Color fundus image
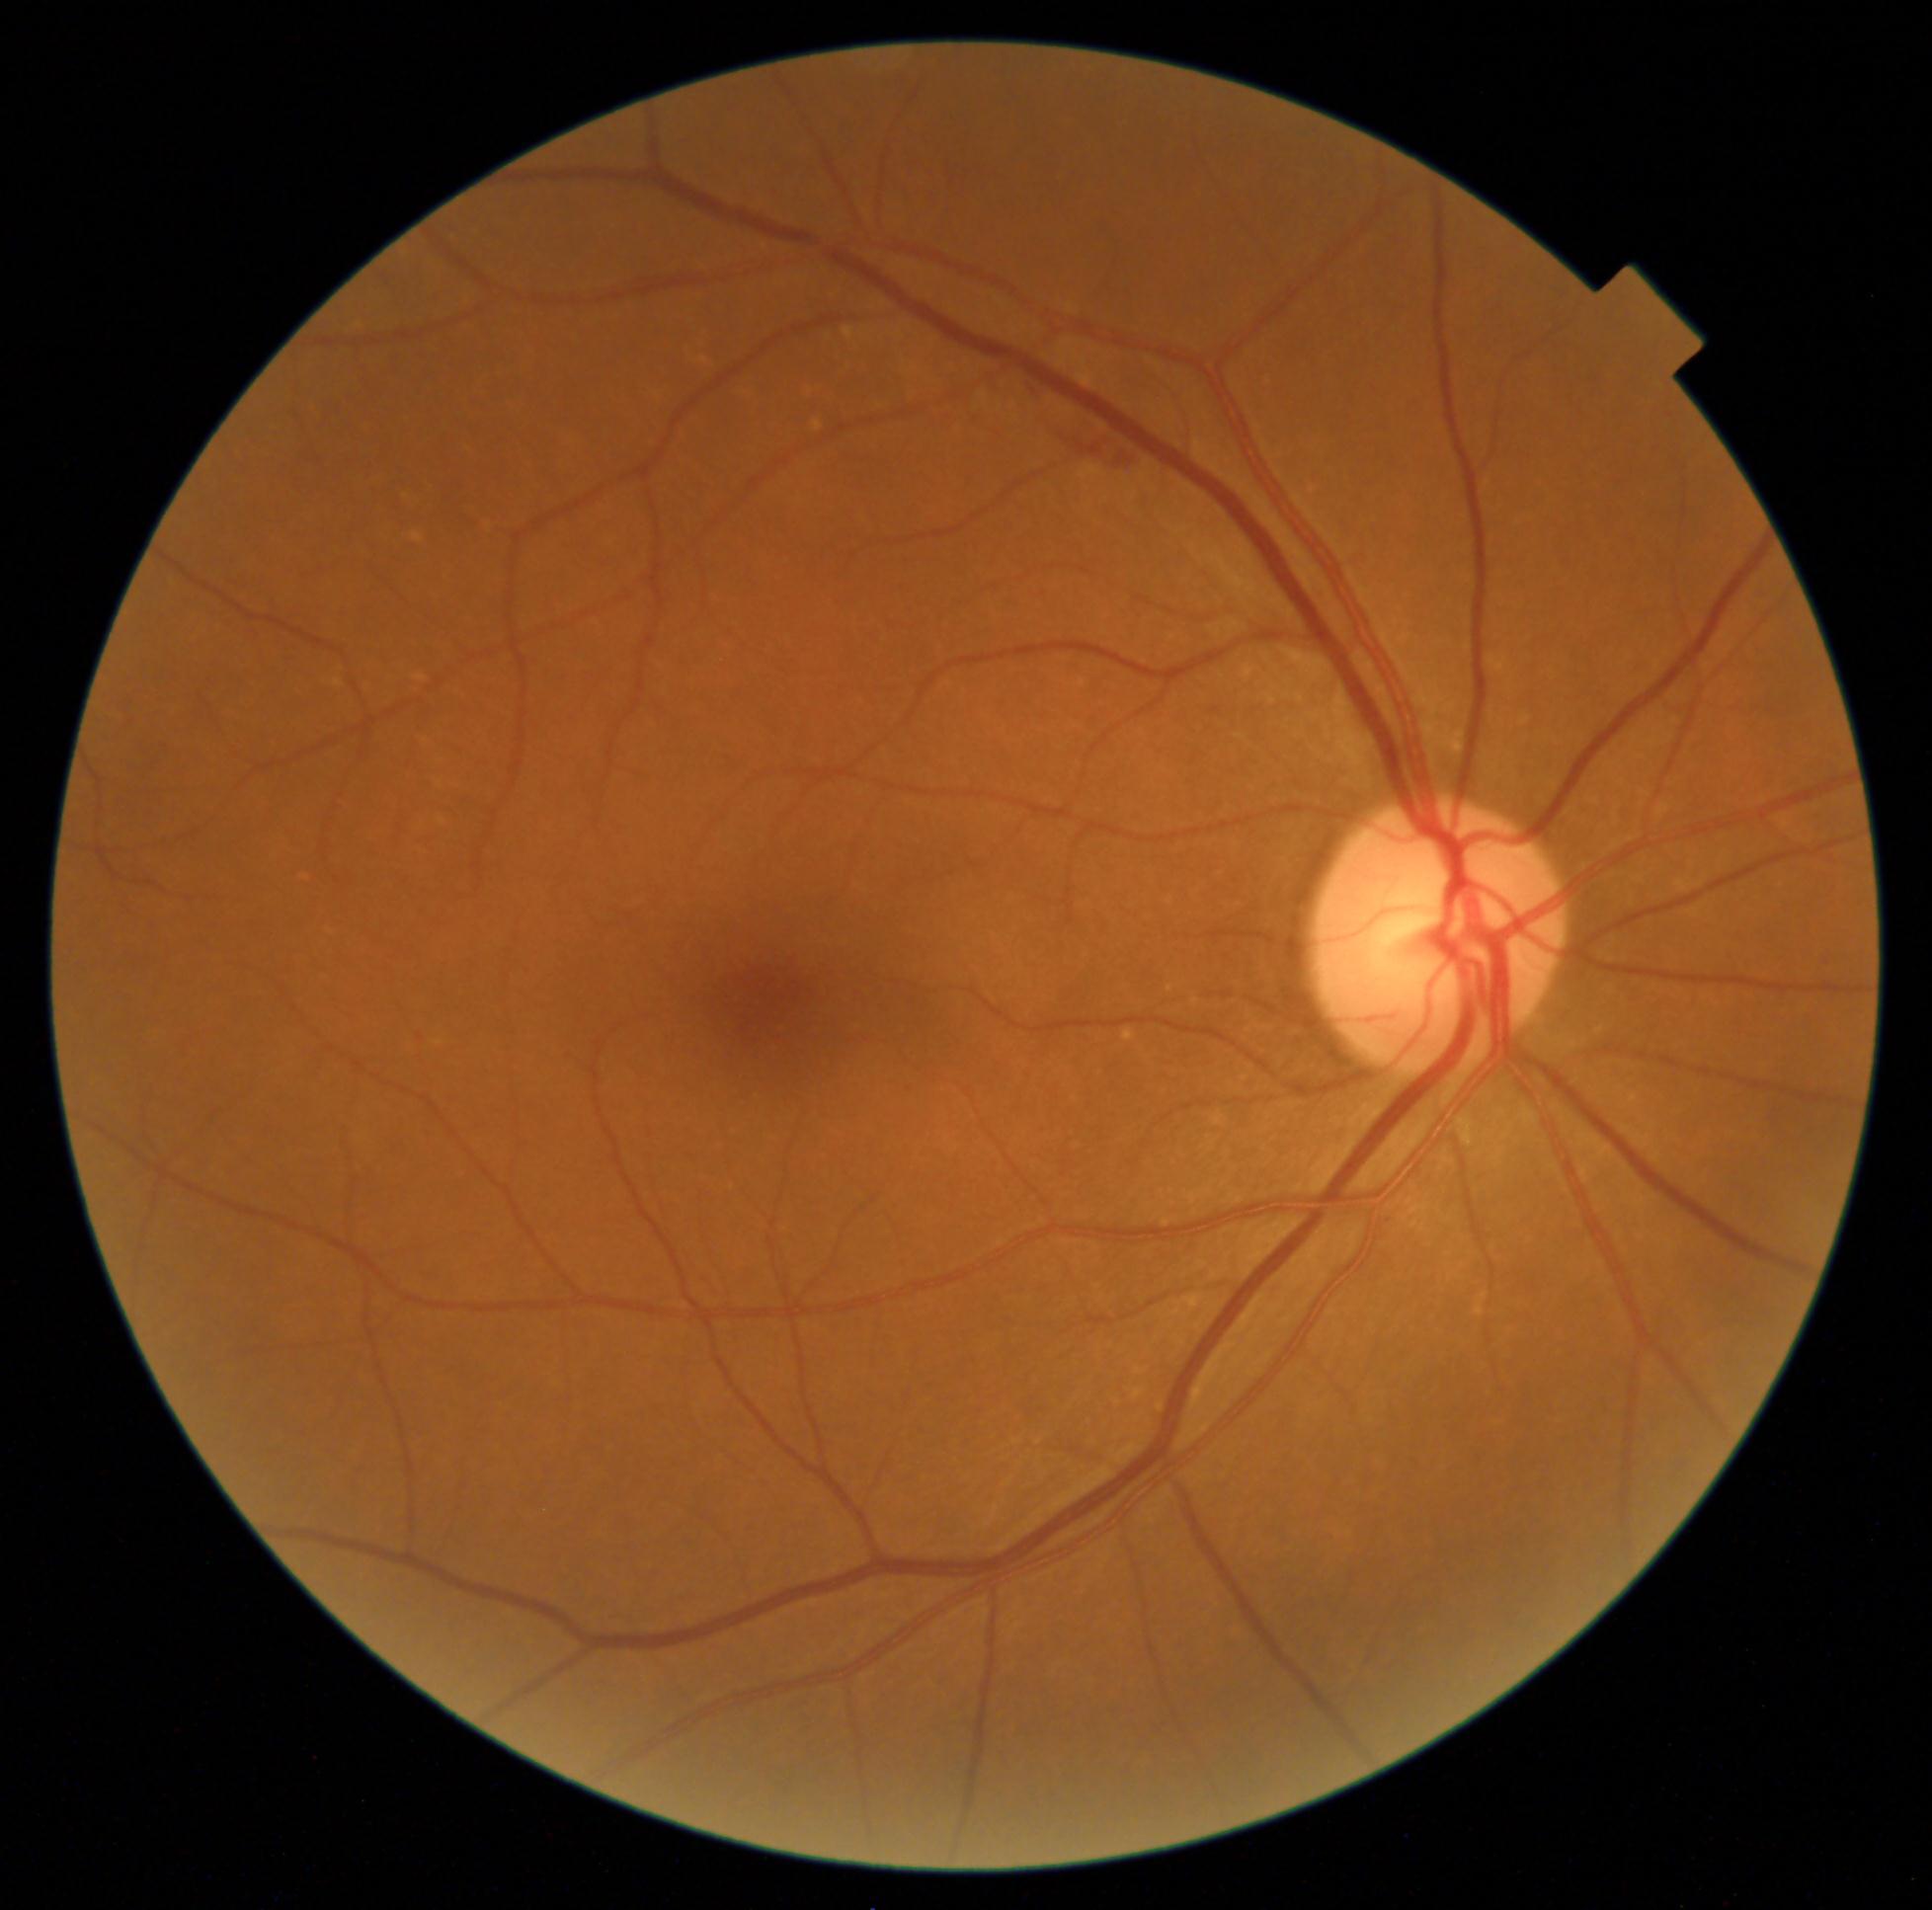
Diabetic retinopathy: 2 — more than just microaneurysms but less than severe NPDR.